Captured with the Phoenix ICON (100° field of view); wide-field fundus image from infant ROP screening; 1240x1240px.
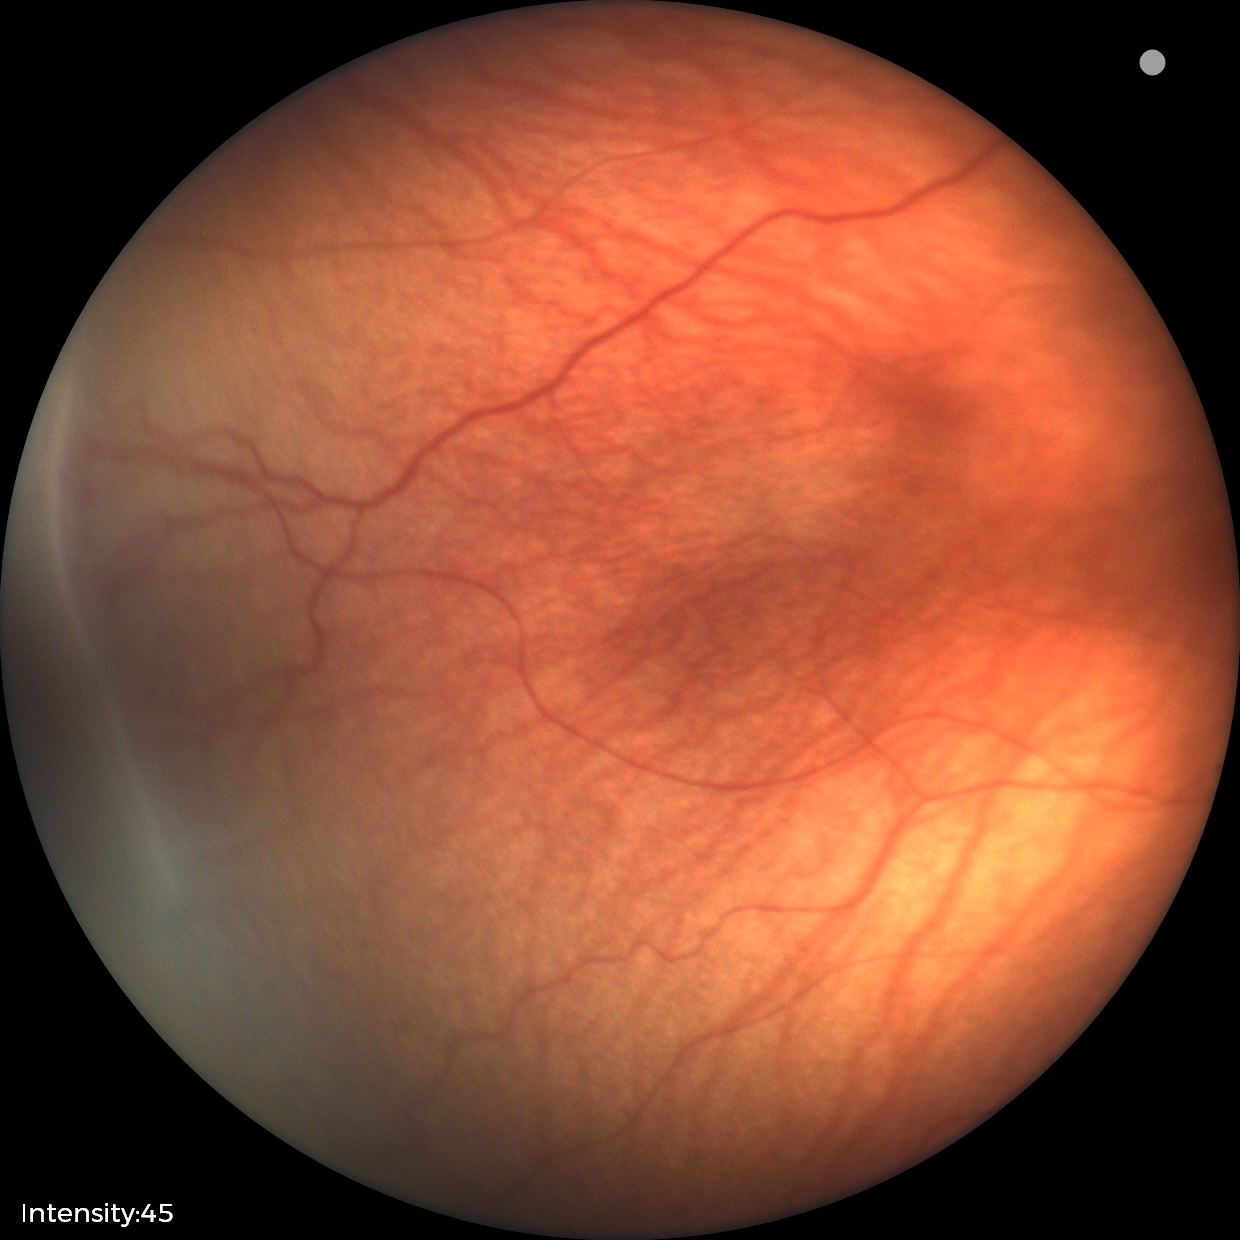 Screening diagnosis: retinopathy of prematurity (ROP) stage 1.